No pharmacologic dilation; 848x848; posterior pole photograph; modified Davis grading; 45-degree field of view; acquired with a NIDEK AFC-230 — 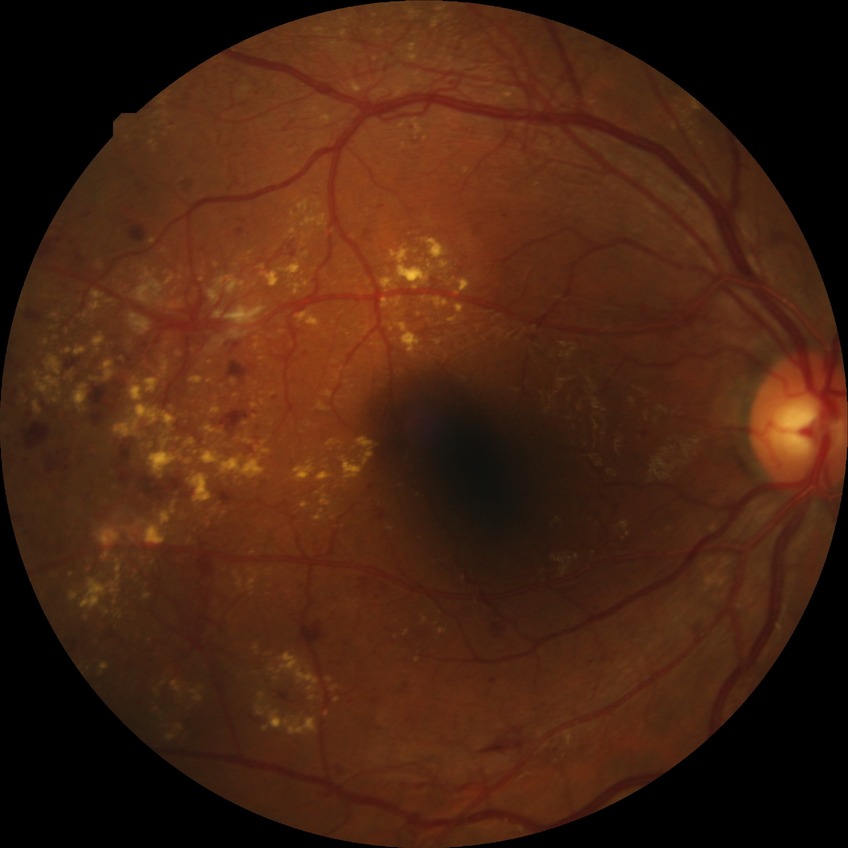

retinopathy stage = proliferative diabetic retinopathy